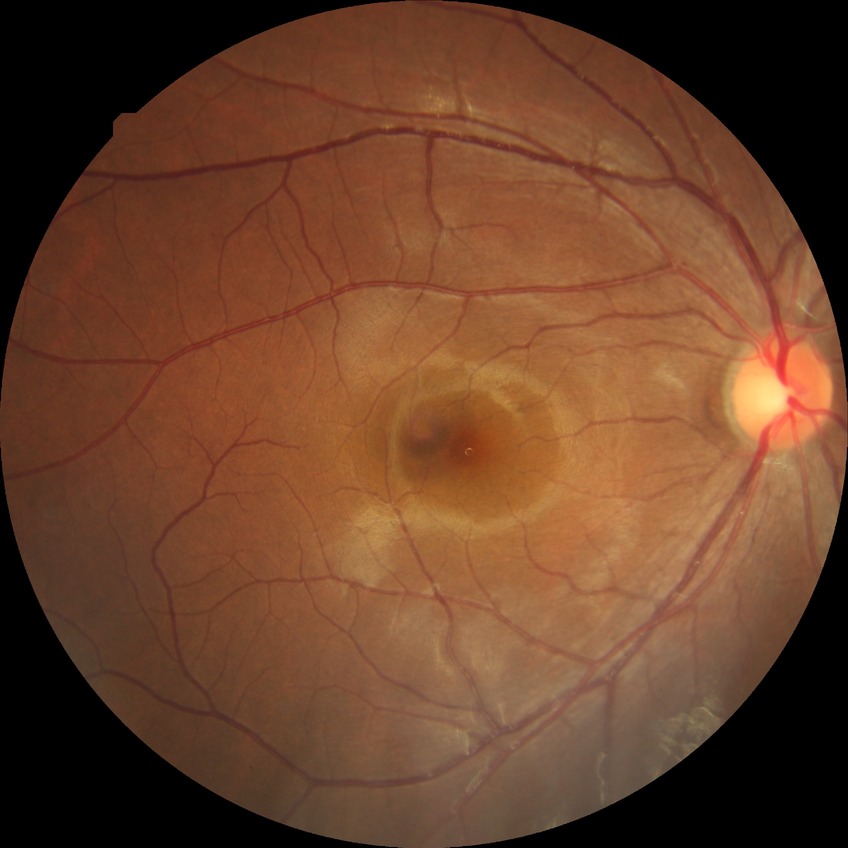 diabetic retinopathy (DR)@NDR (no diabetic retinopathy).